Camera: NIDEK AFC-230; without pupil dilation — 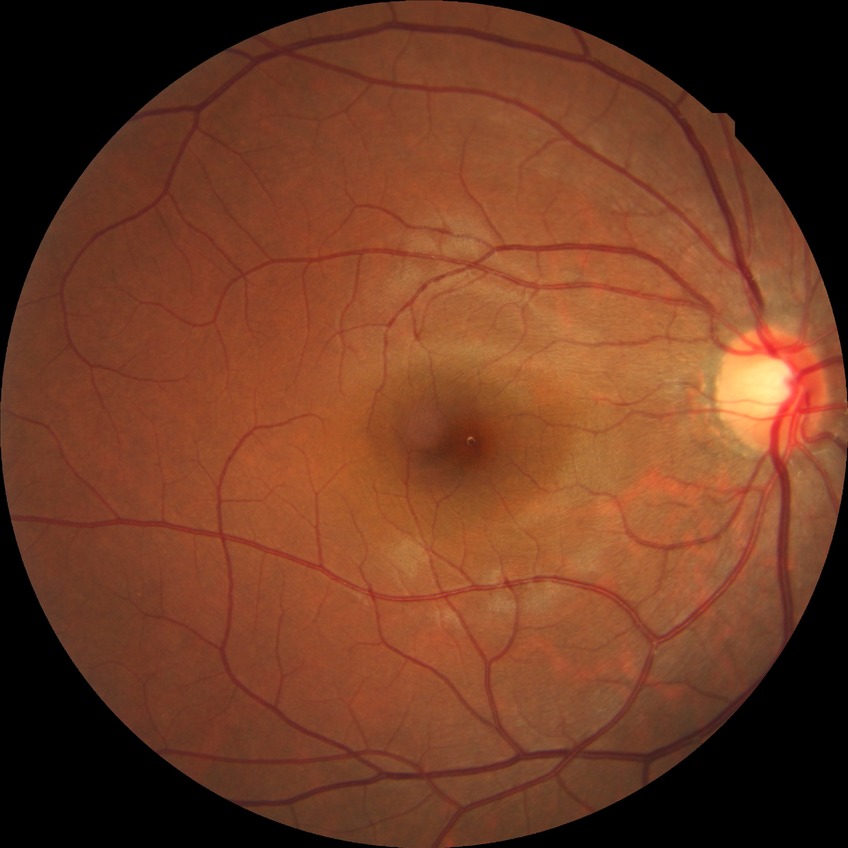
Davis stage: NDR. No signs of diabetic retinopathy.